2212x1659px · retinal fundus photograph · 45° FOV: 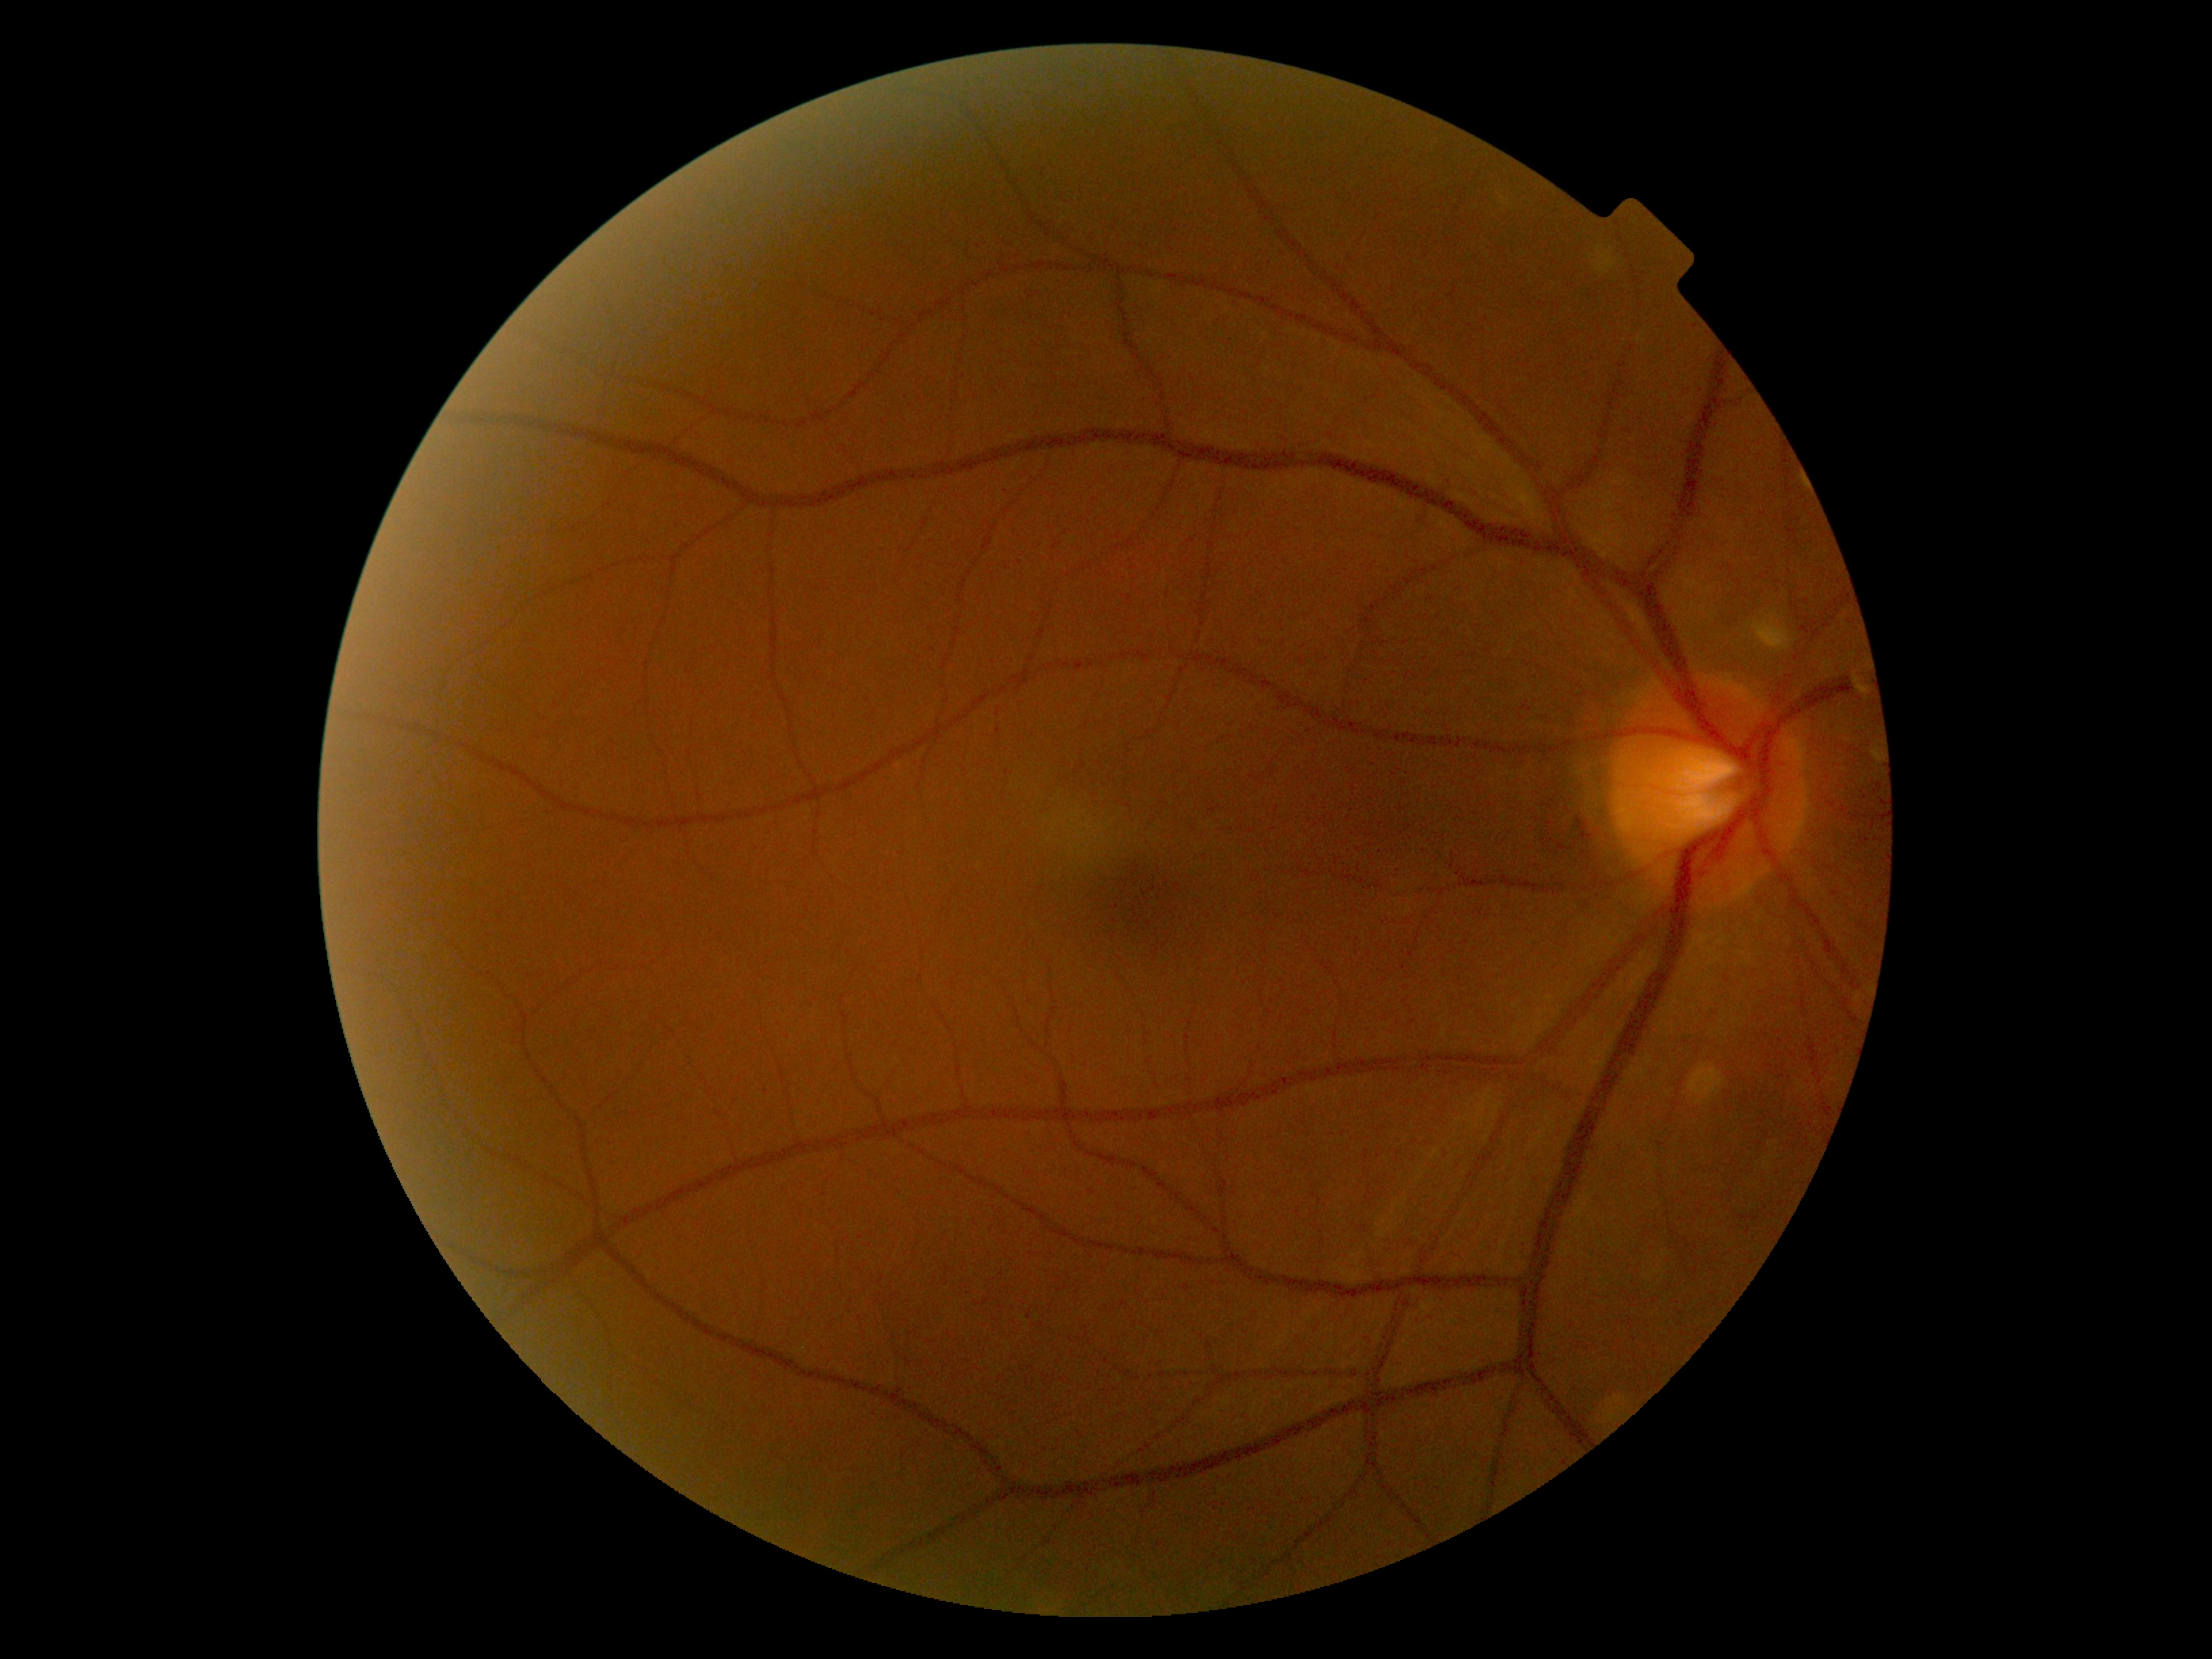

{
  "dr_grade": "no apparent retinopathy (grade 0)"
}